Fundus photo · image size 512x512:
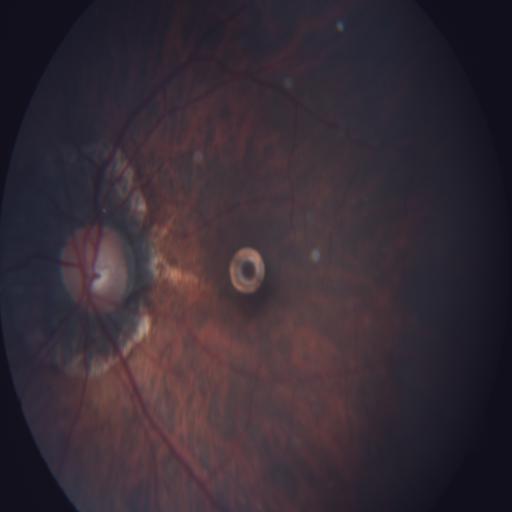
Showing myopia.